Acquired with a Remidio FOP fundus camera:
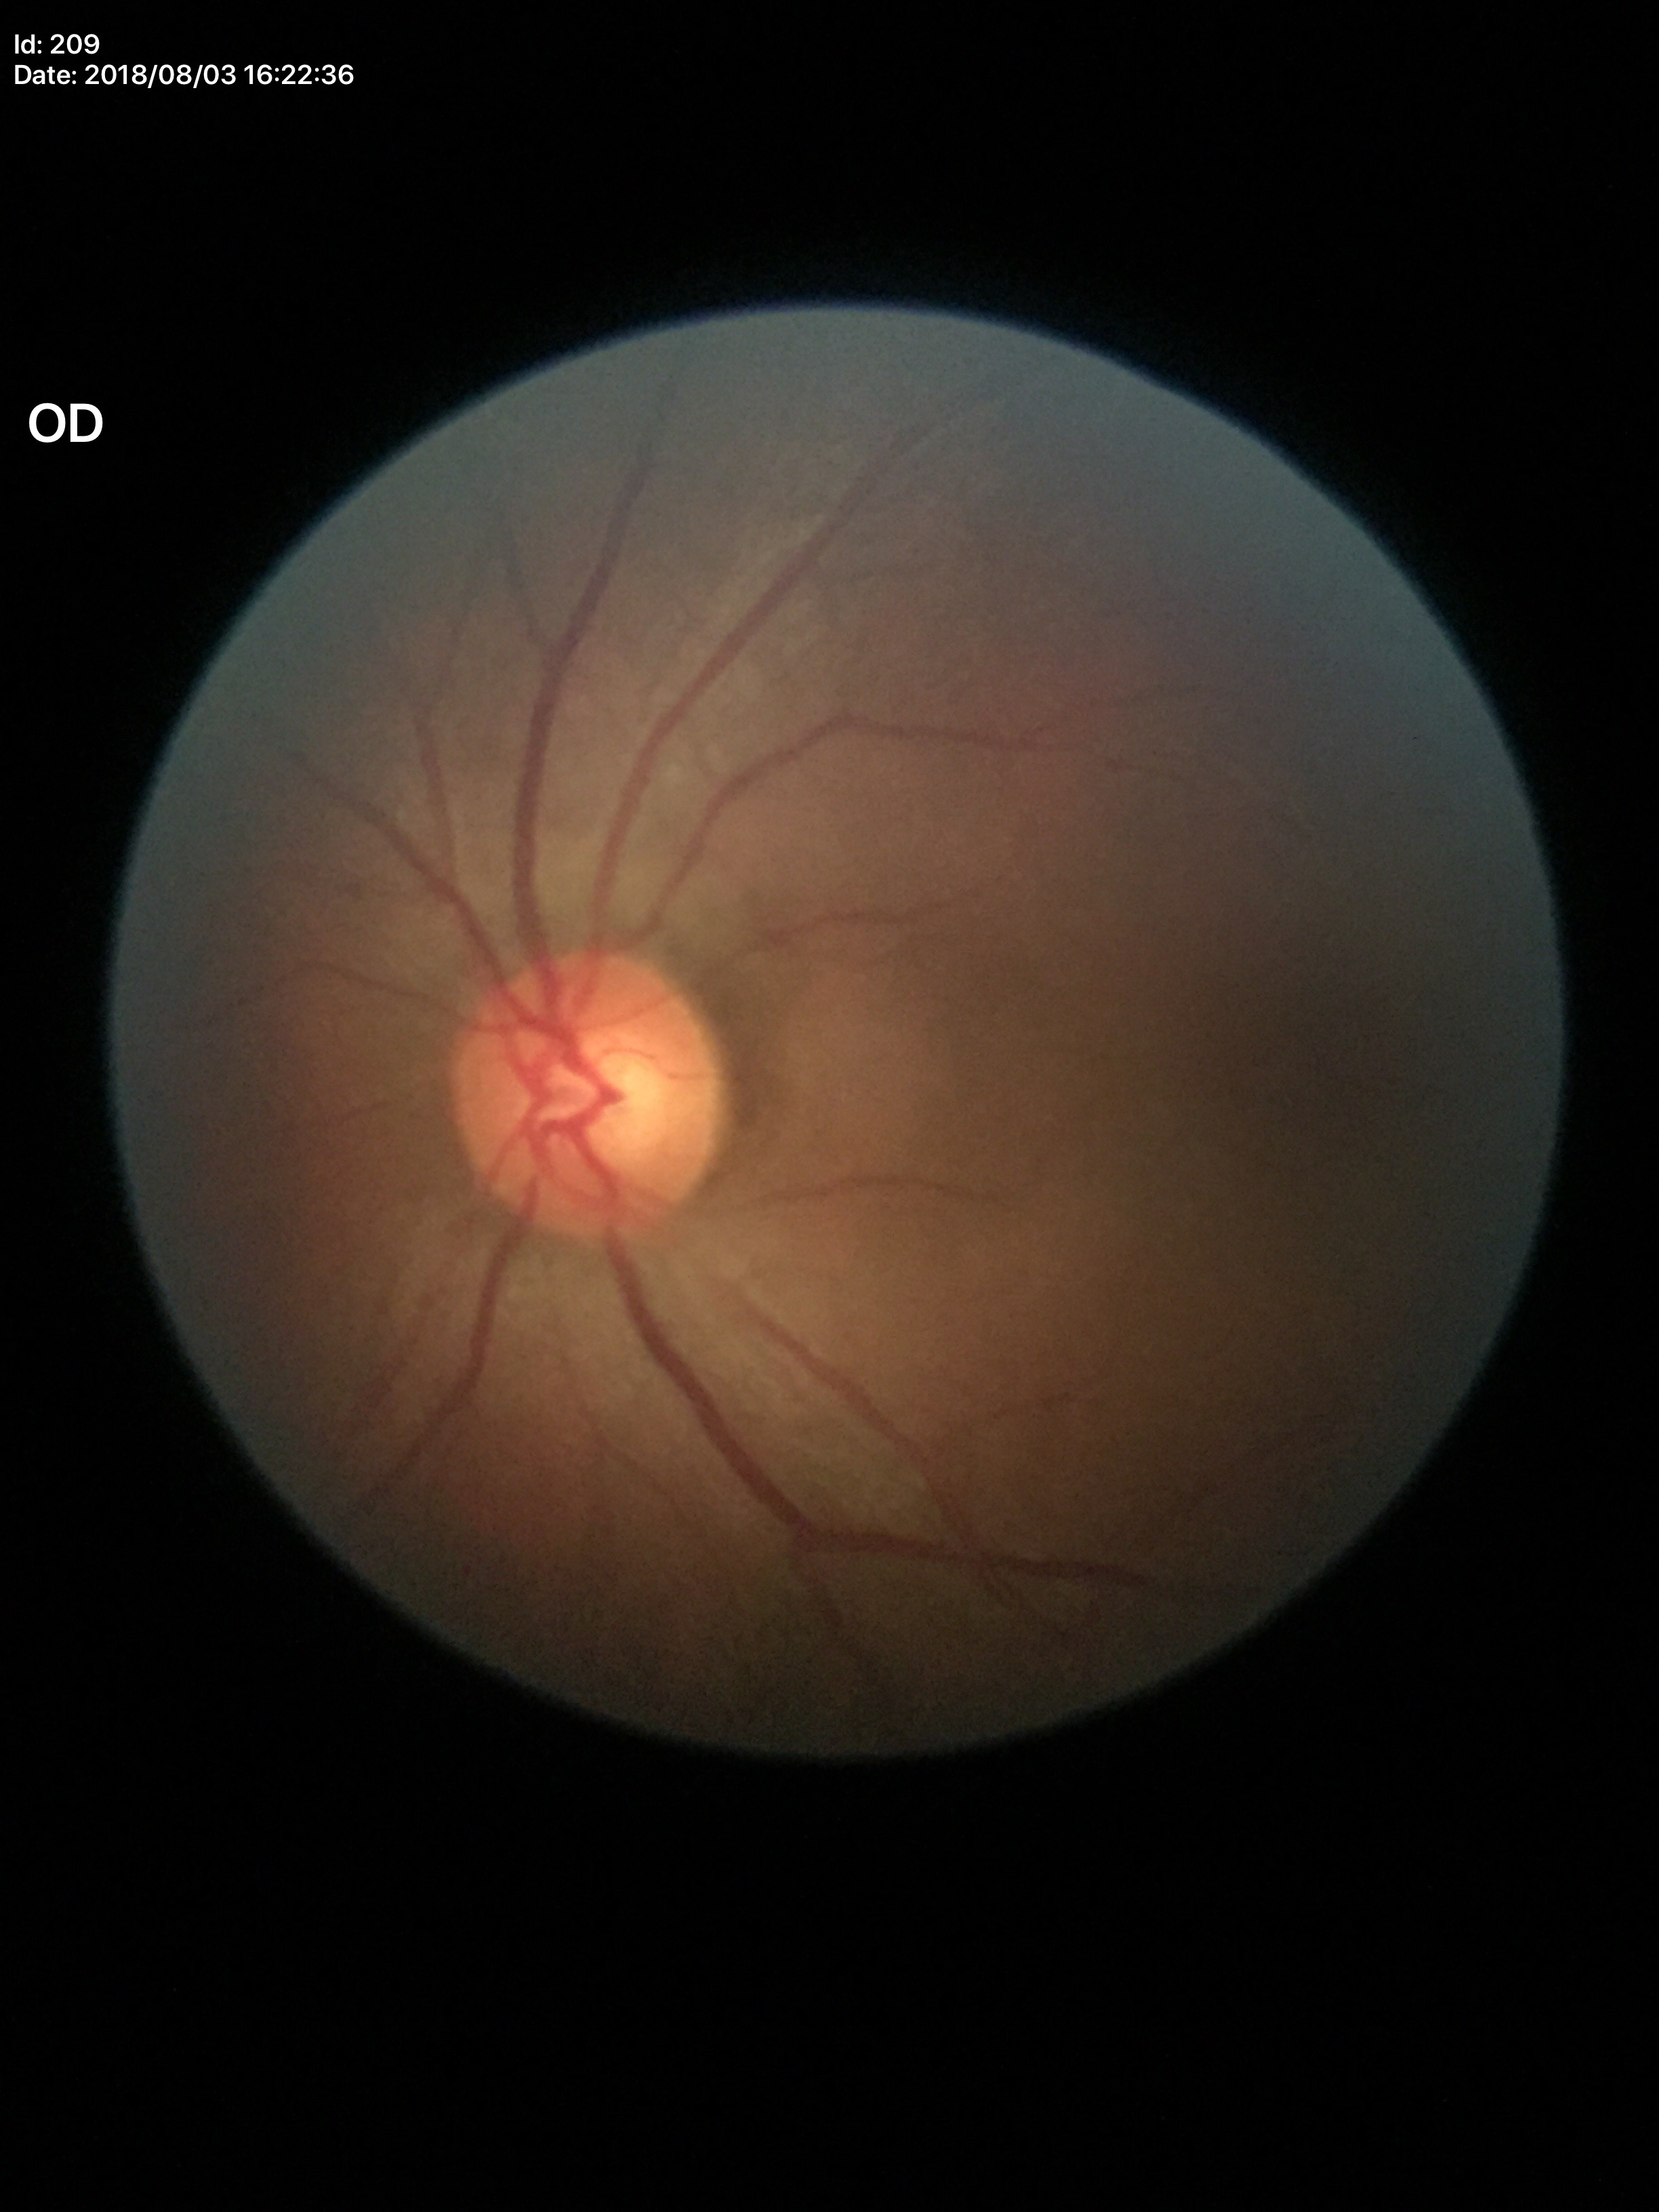

glaucoma_decision: negative
vcdr: 0.53